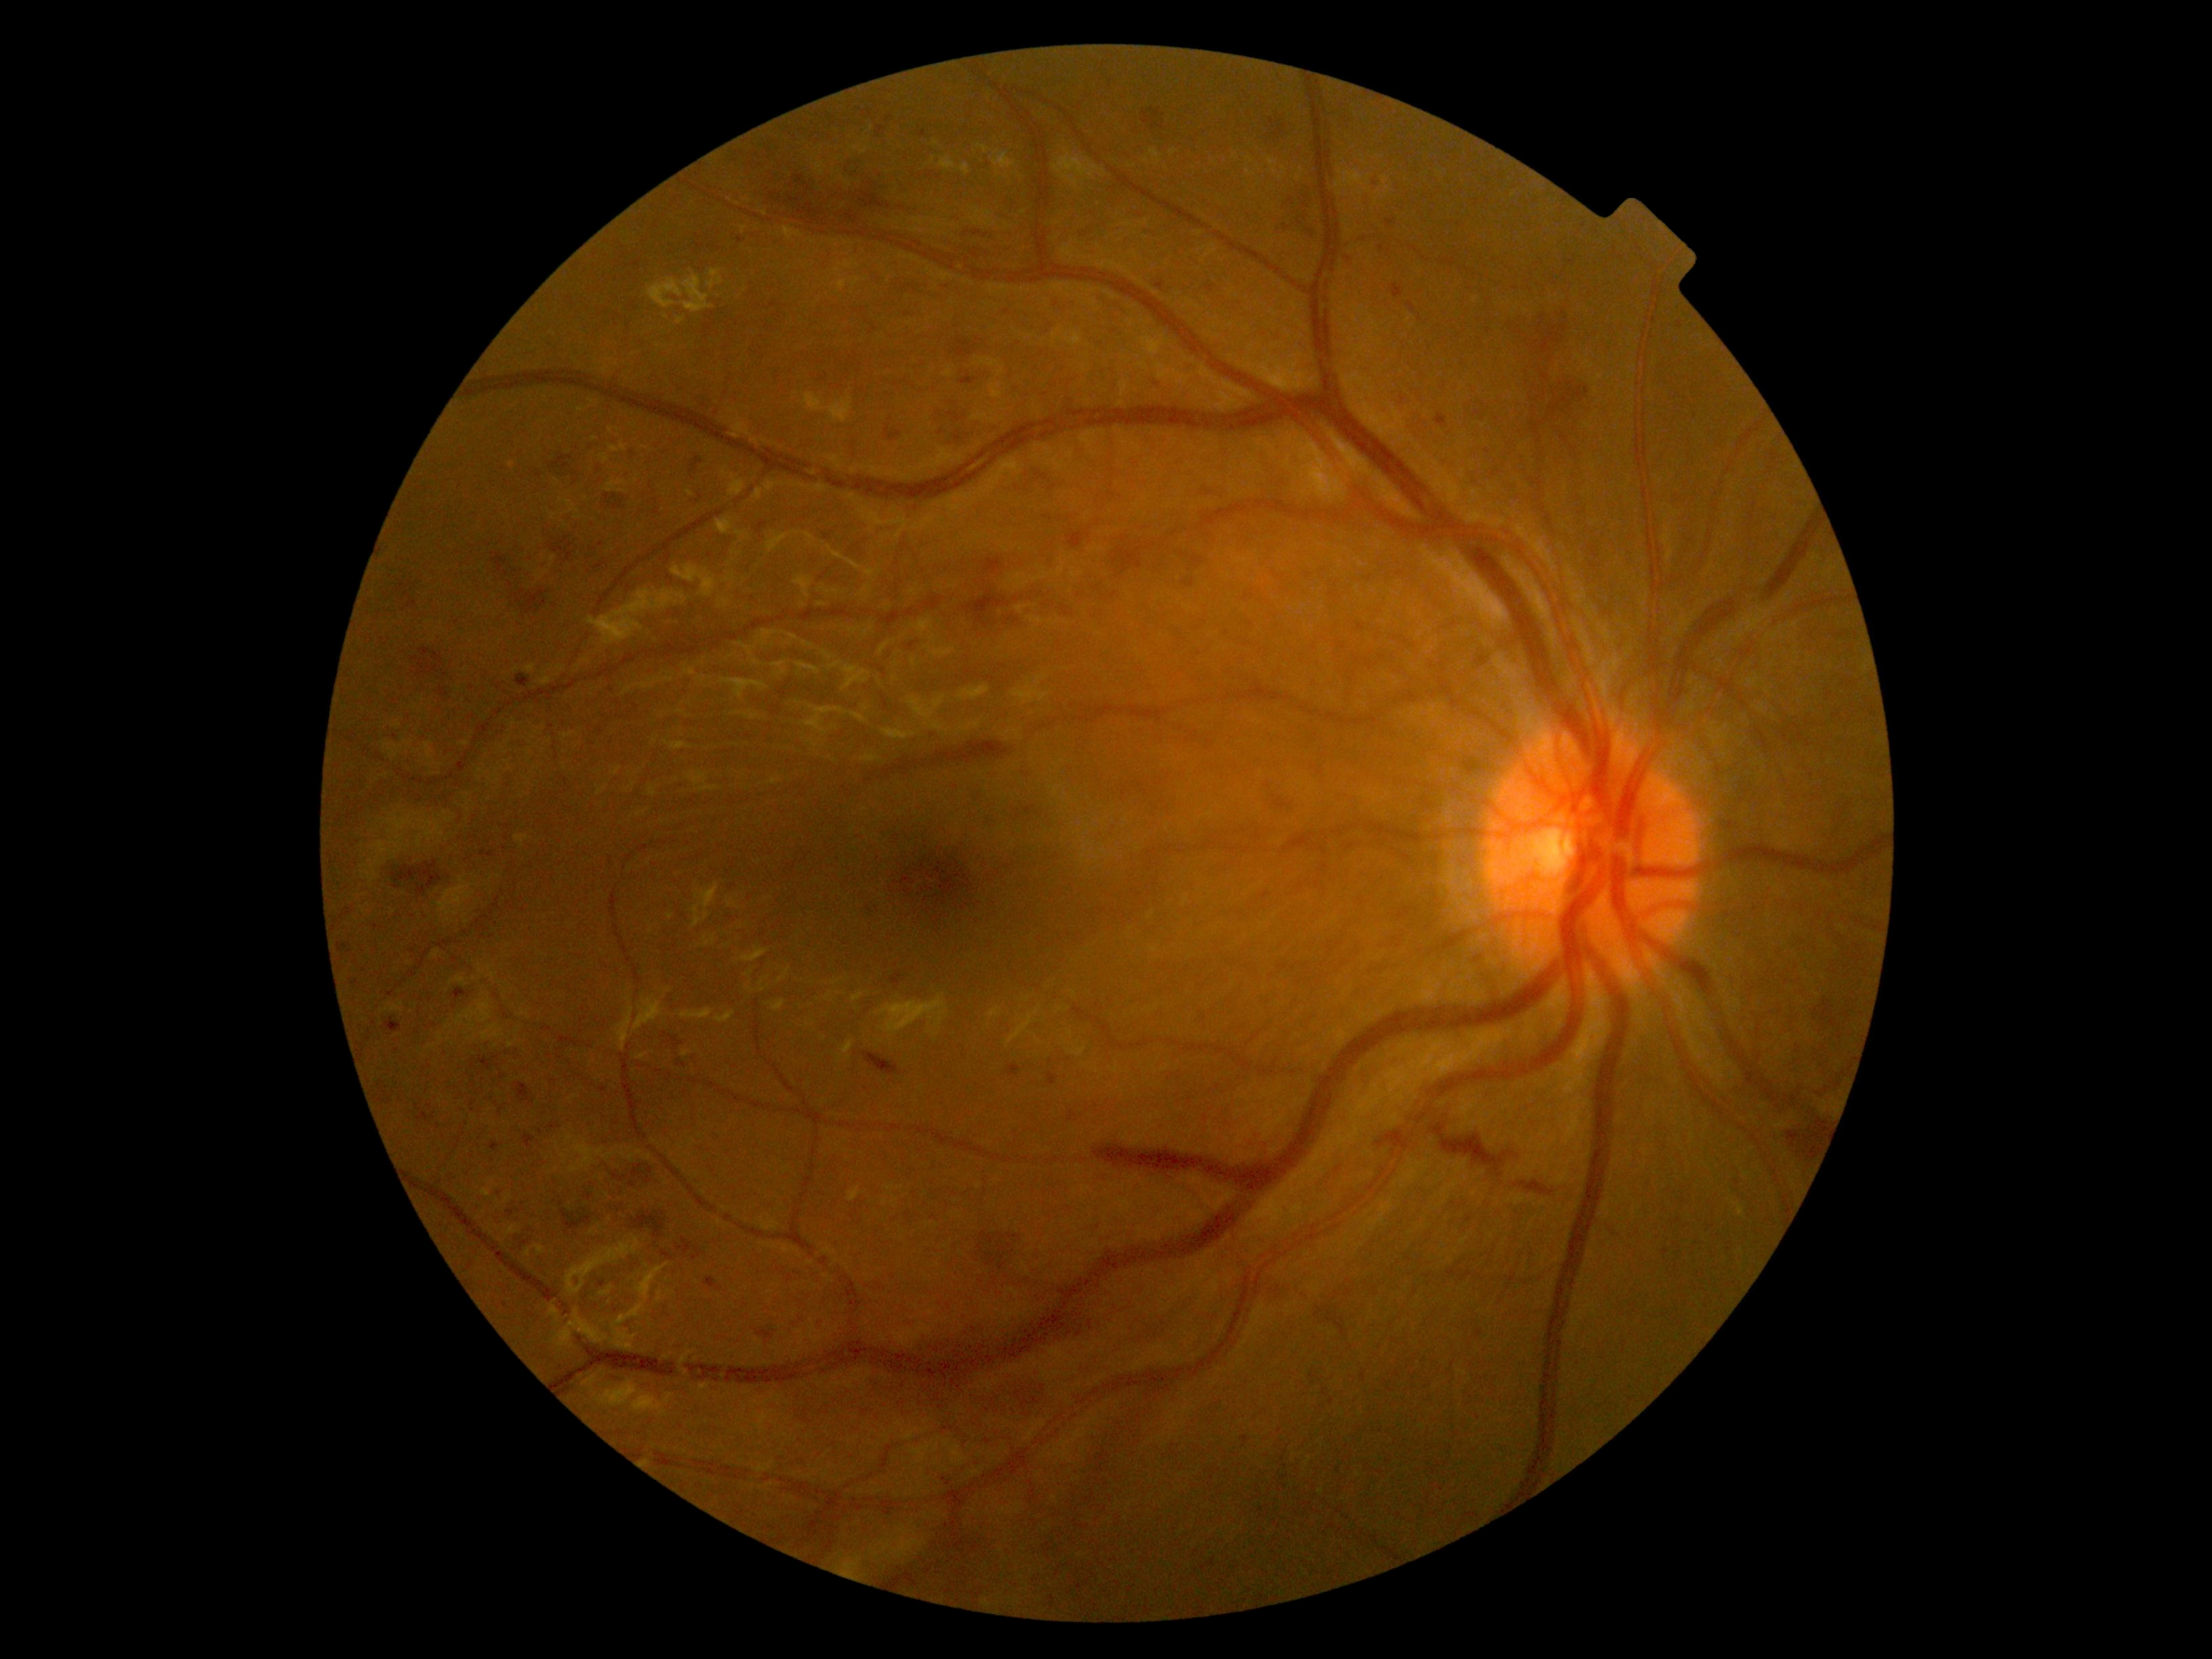
<lesions partial="true">
  <dr_grade>3</dr_grade>
  <he partial="true">415/884/426/895 | 514/1082/533/1104 | 1386/219/1395/227 | 631/1164/642/1179 | 403/592/418/609 | 1391/284/1405/299 | 863/1052/901/1076 | 653/509/661/514 | 1435/413/1447/428 | 974/1372/1073/1432 | 414/649/456/701 | 1408/303/1417/314 | 510/1227/537/1250</he>
  <he_small_centers>1086:1160 | 1114:332 | 500:1193 | 431:1106 | 604:1090 | 650:1169</he_small_centers>
</lesions>